NIDEK AFC-230 · without pupil dilation · FOV: 45 degrees · 848 by 848 pixels
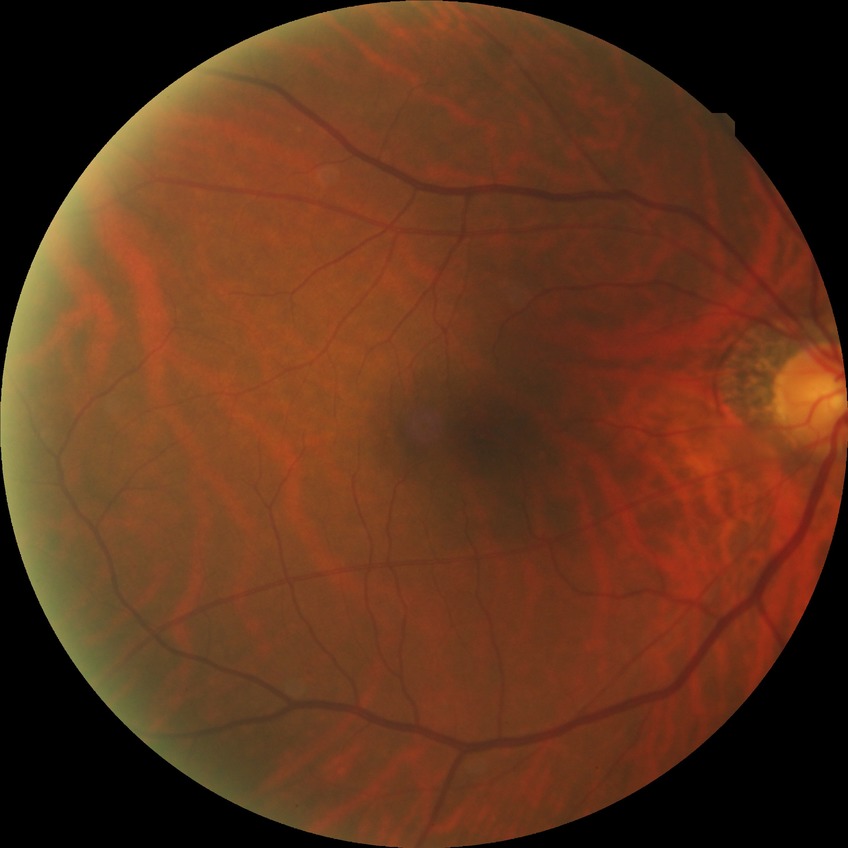

diabetic retinopathy (DR): no diabetic retinopathy (NDR).